Central corneal thickness: 548 µm · age 69 · female patient · refraction: +0.25 -1.25 × 80° · intraocular pressure (IOP) 12 mmHg — 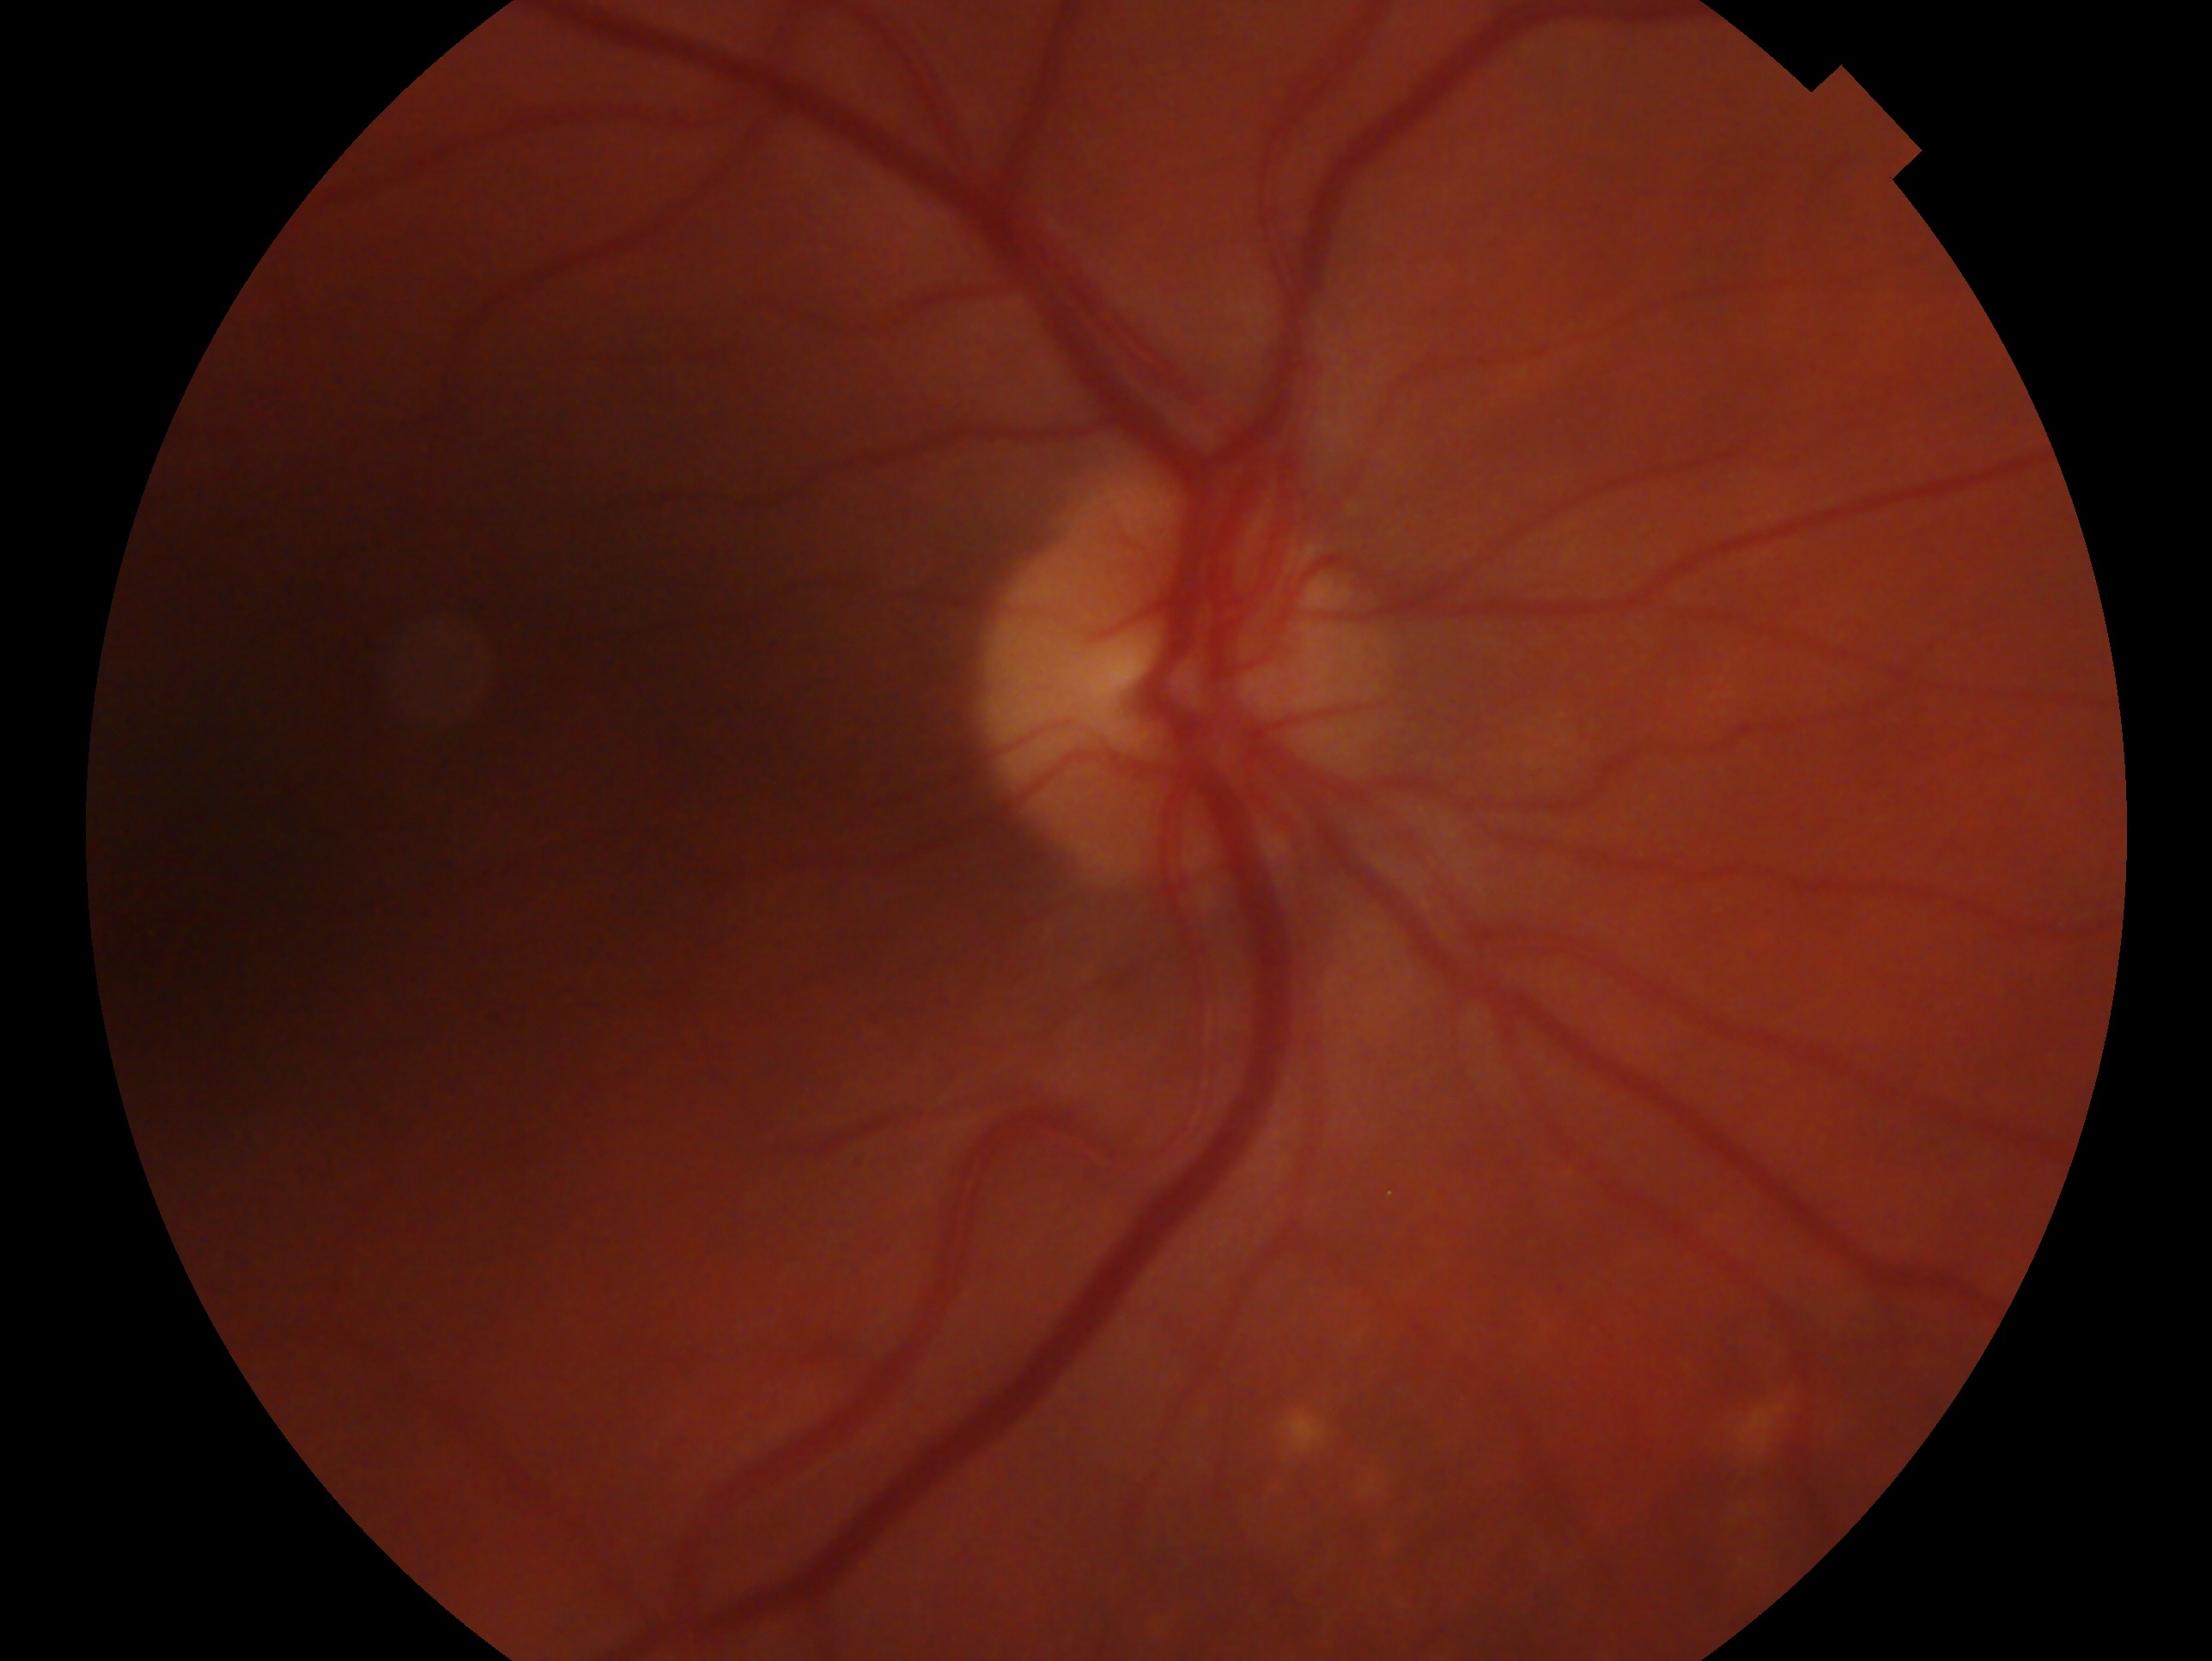

Annotations:
* laterality — oculus dexter
* assessment — no glaucomatous findings